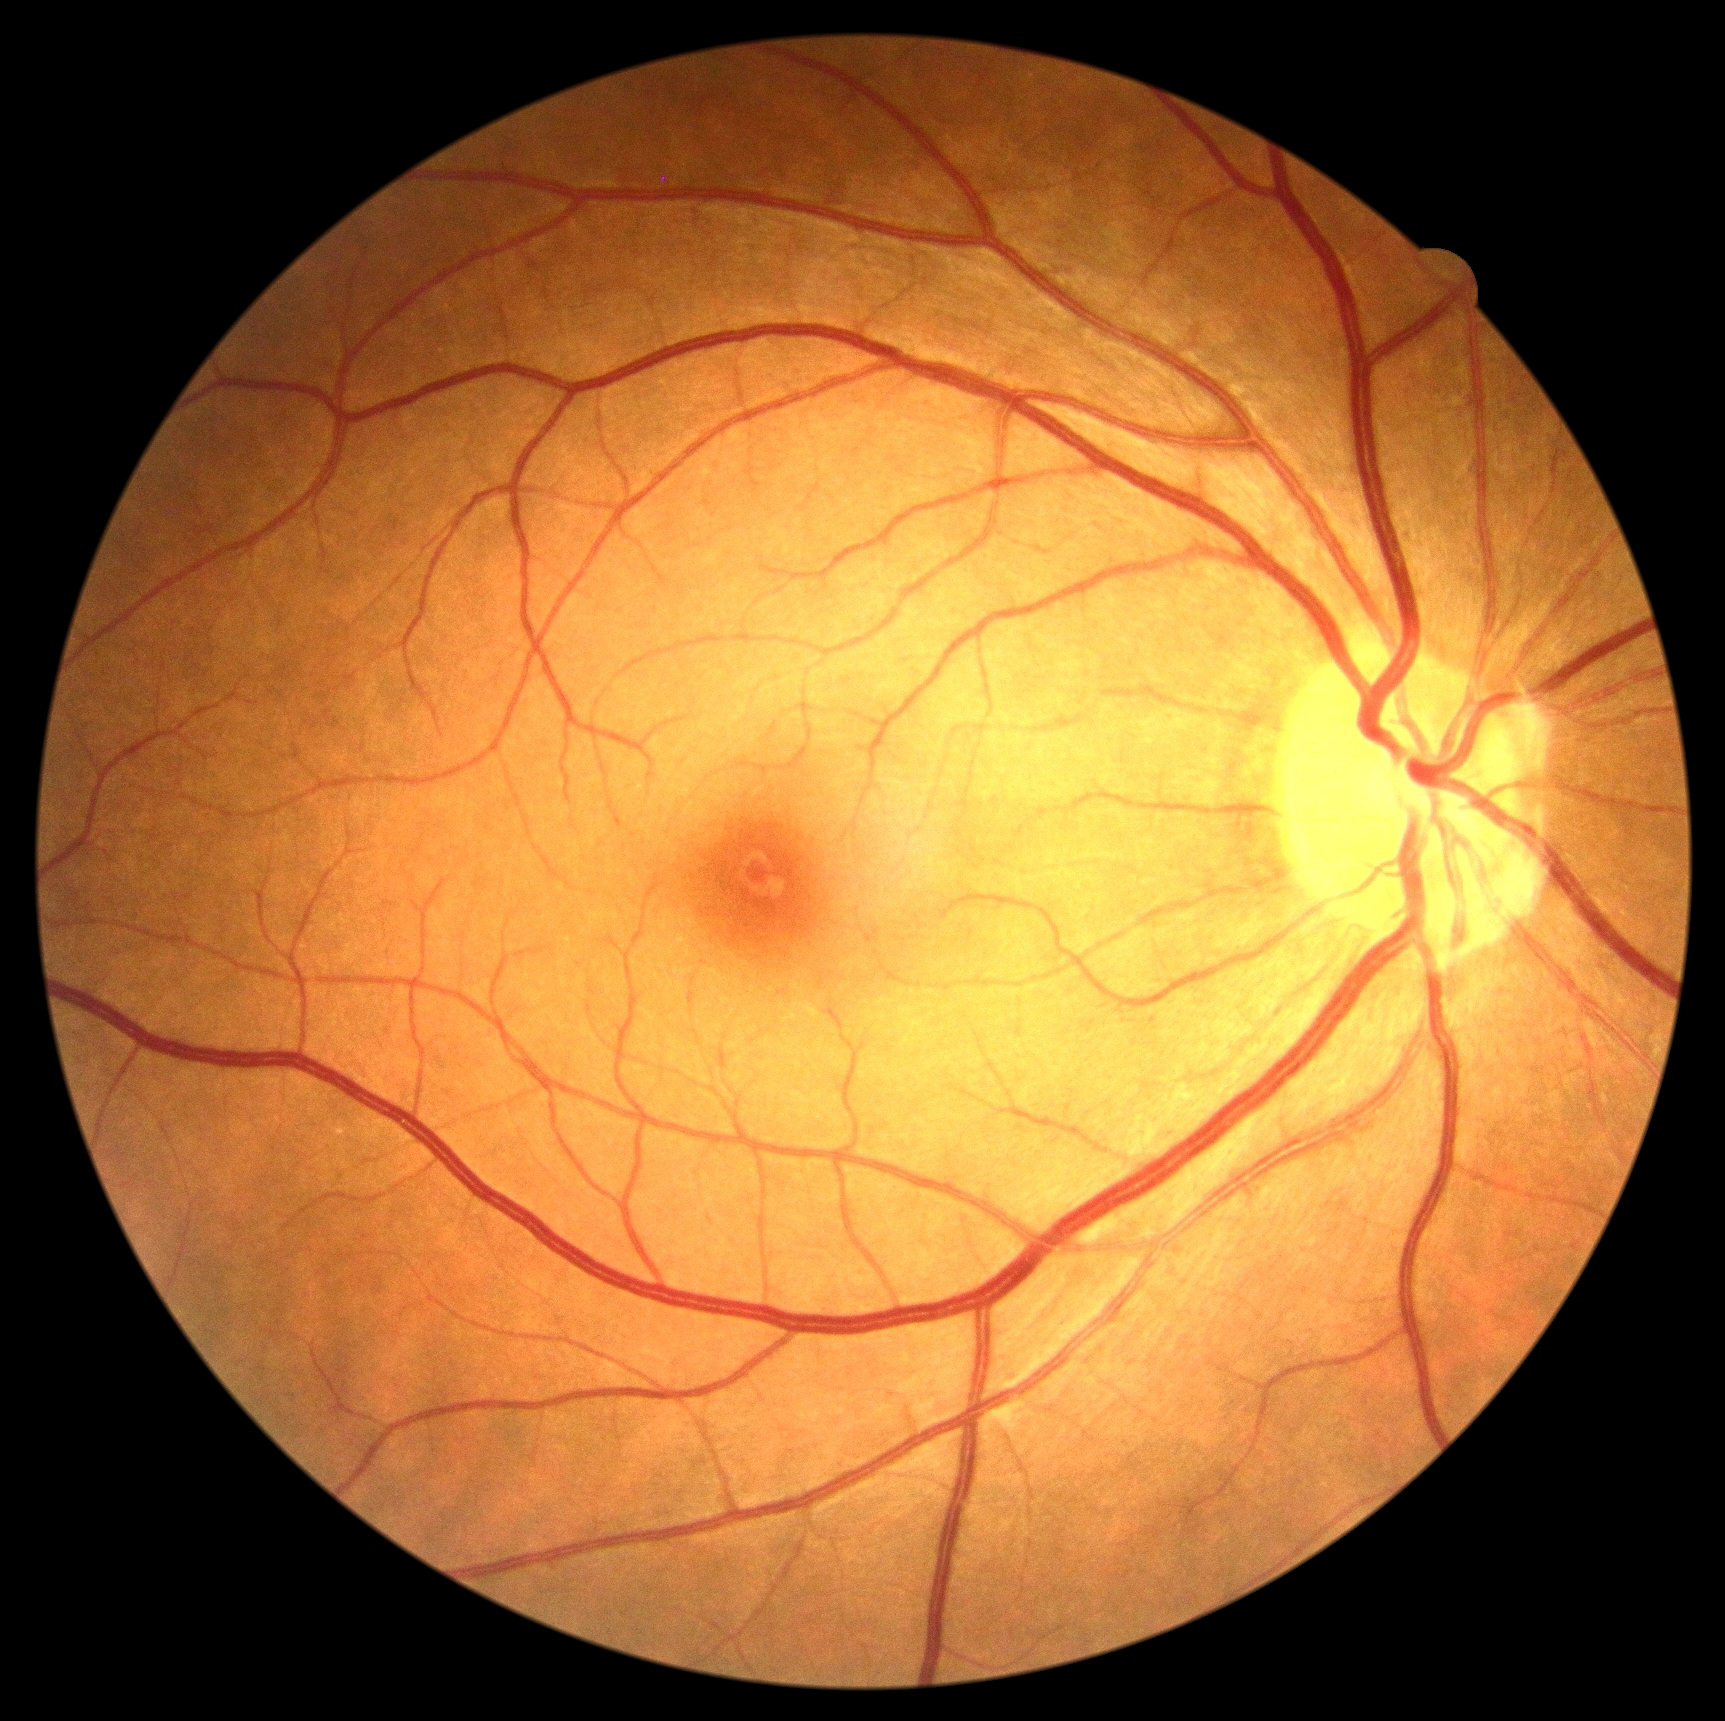

Diabetic retinopathy (DR): no apparent retinopathy (grade 0).